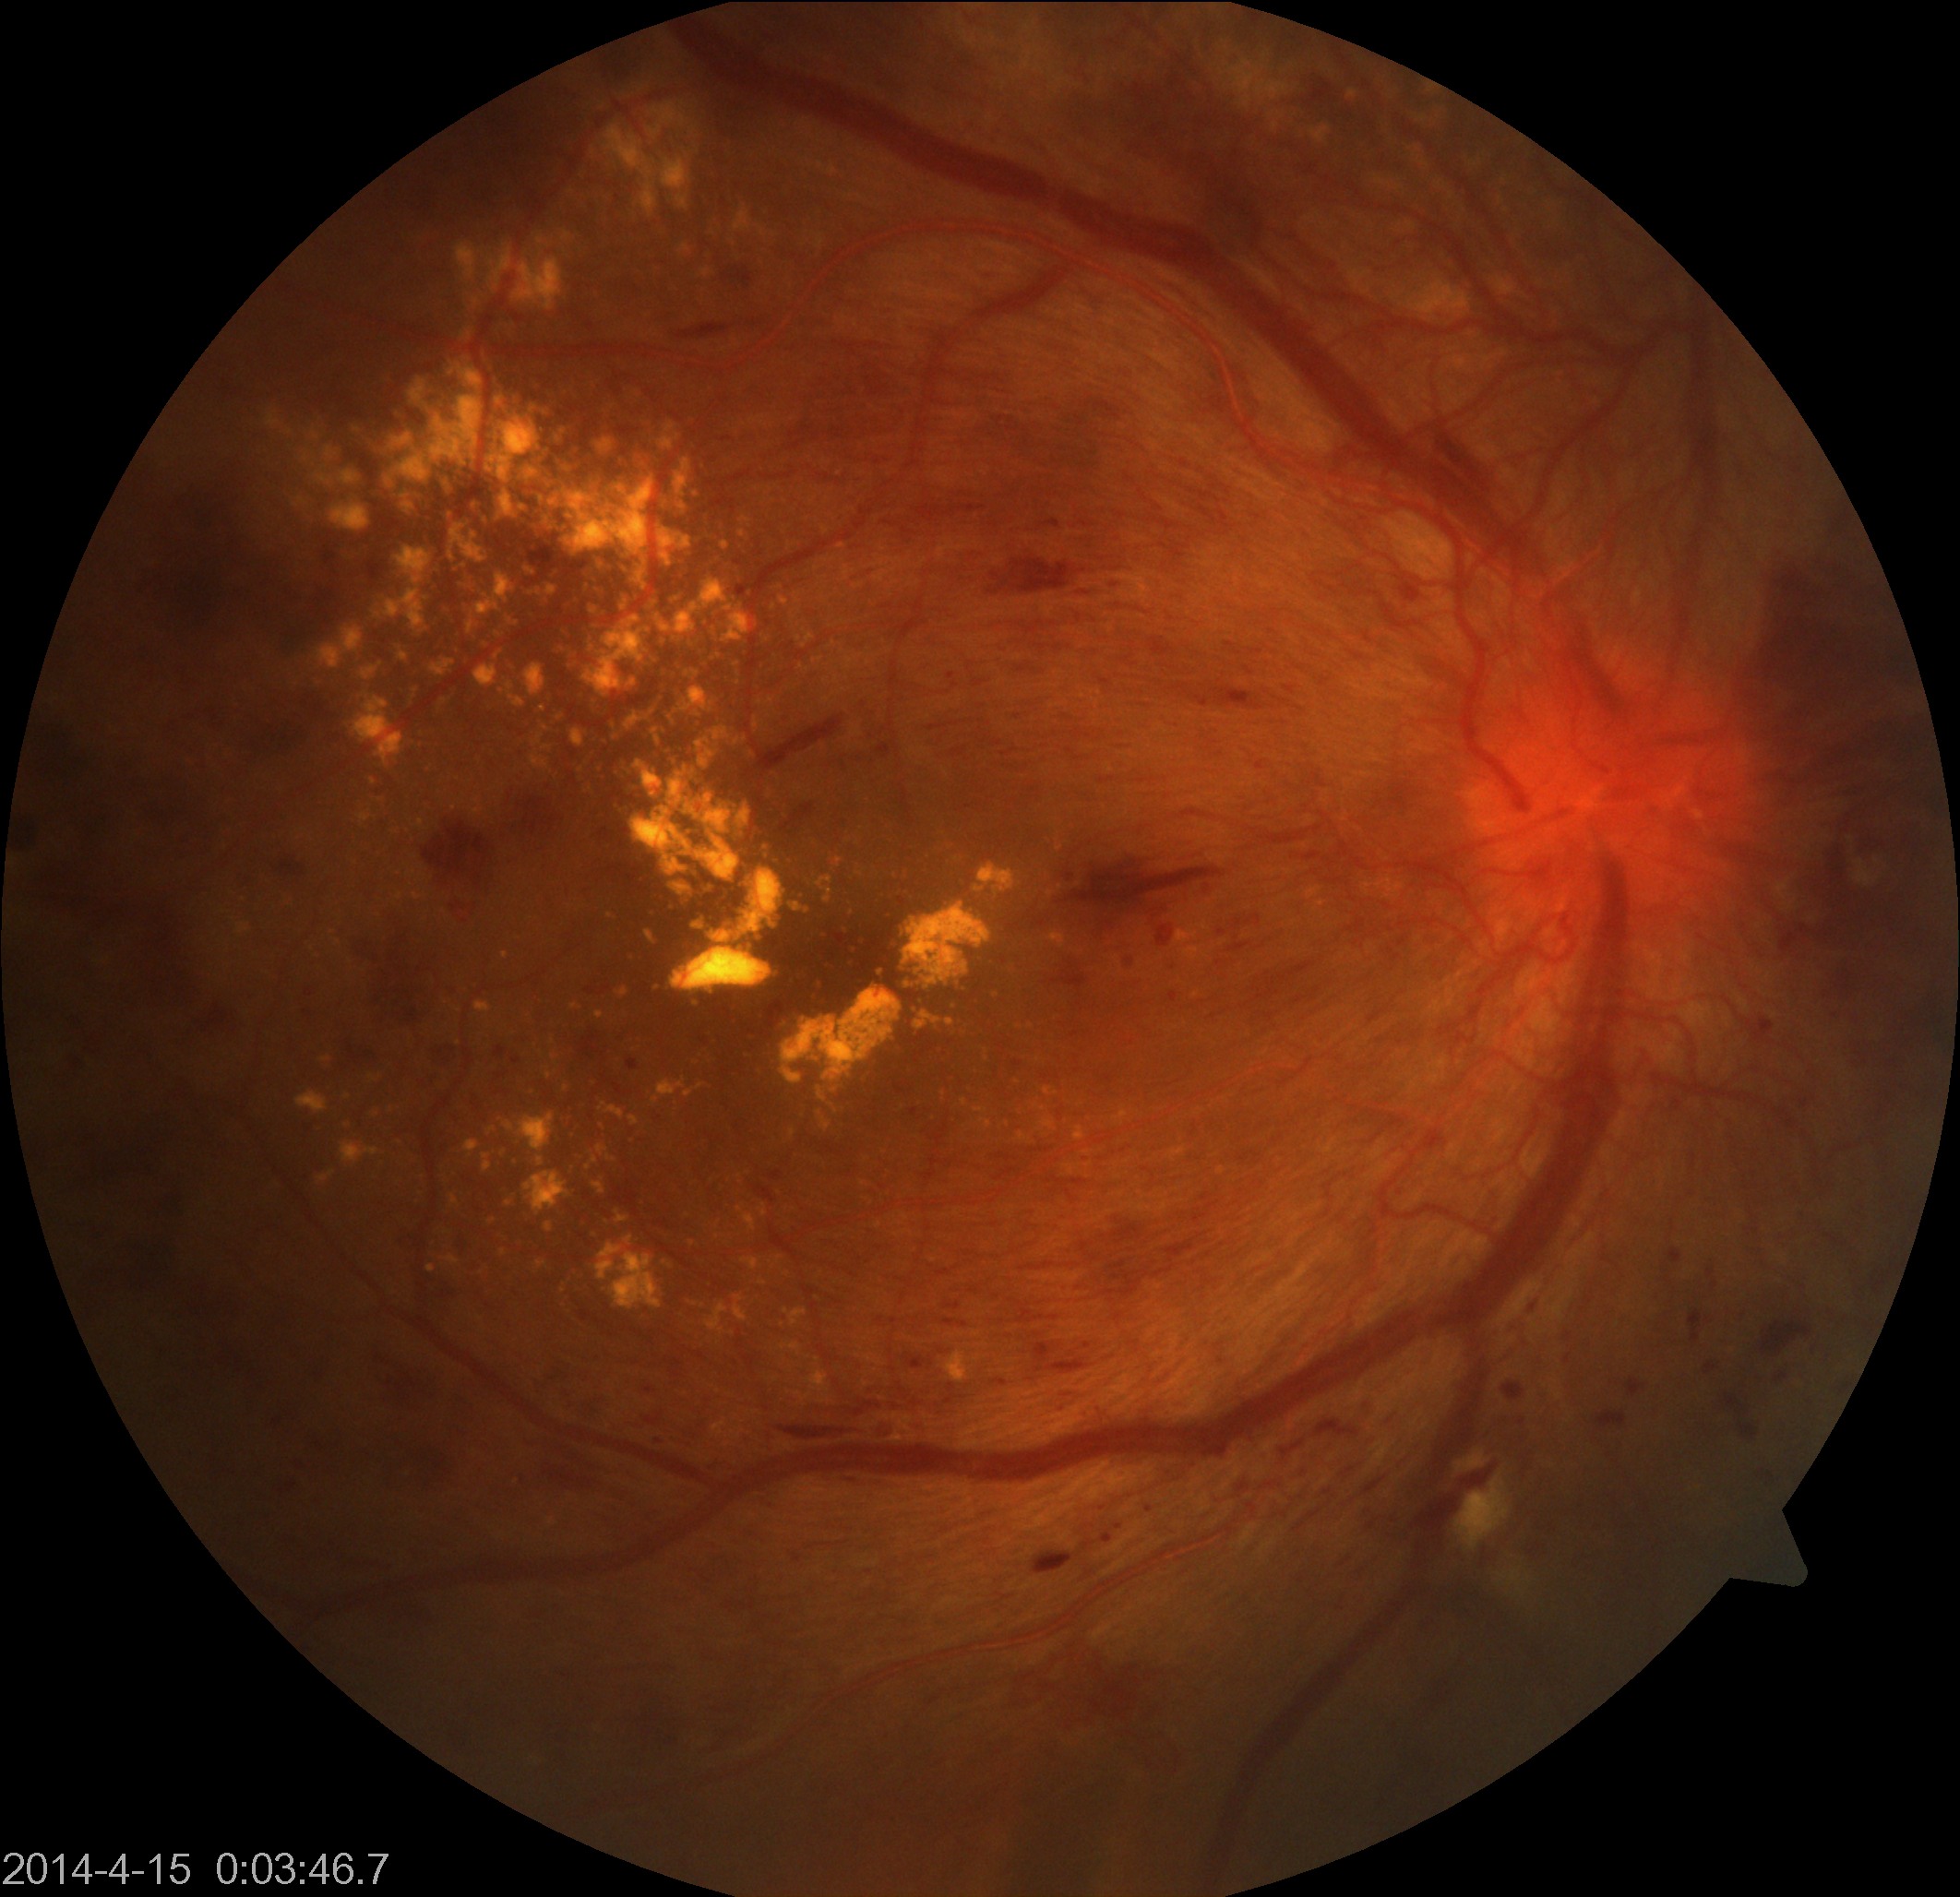

This fundus photograph shows severe non-proliferative or proliferative diabetic retinopathy.